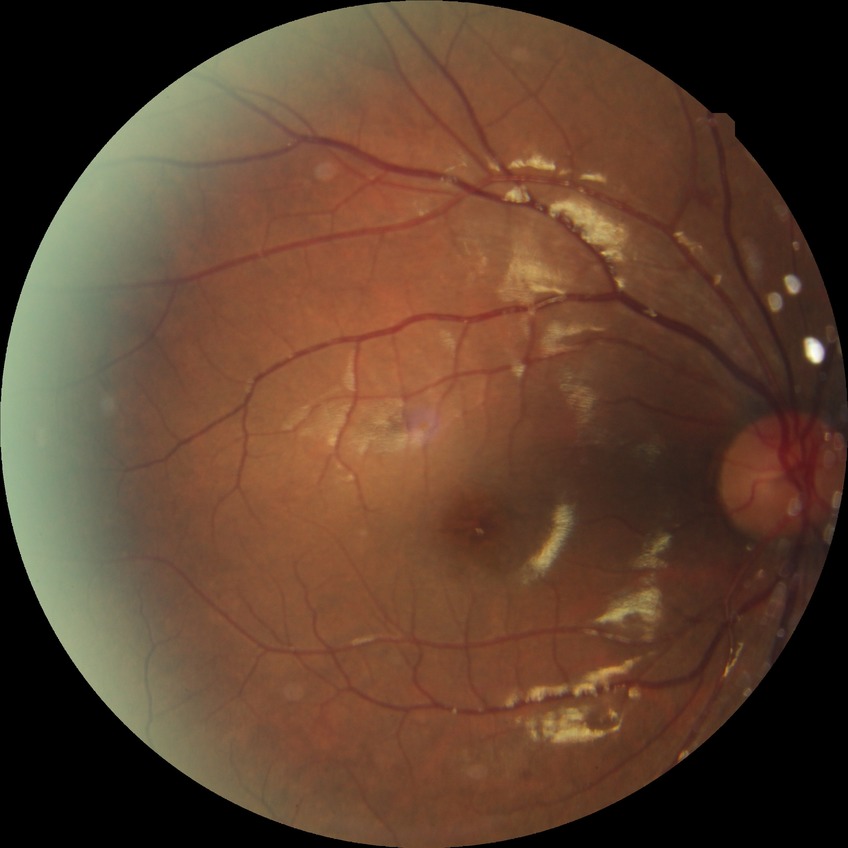 Davis grading=simple diabetic retinopathy.